Phoenix ICON, 100° FOV. 1240x1240. Wide-field fundus photograph from neonatal ROP screening: 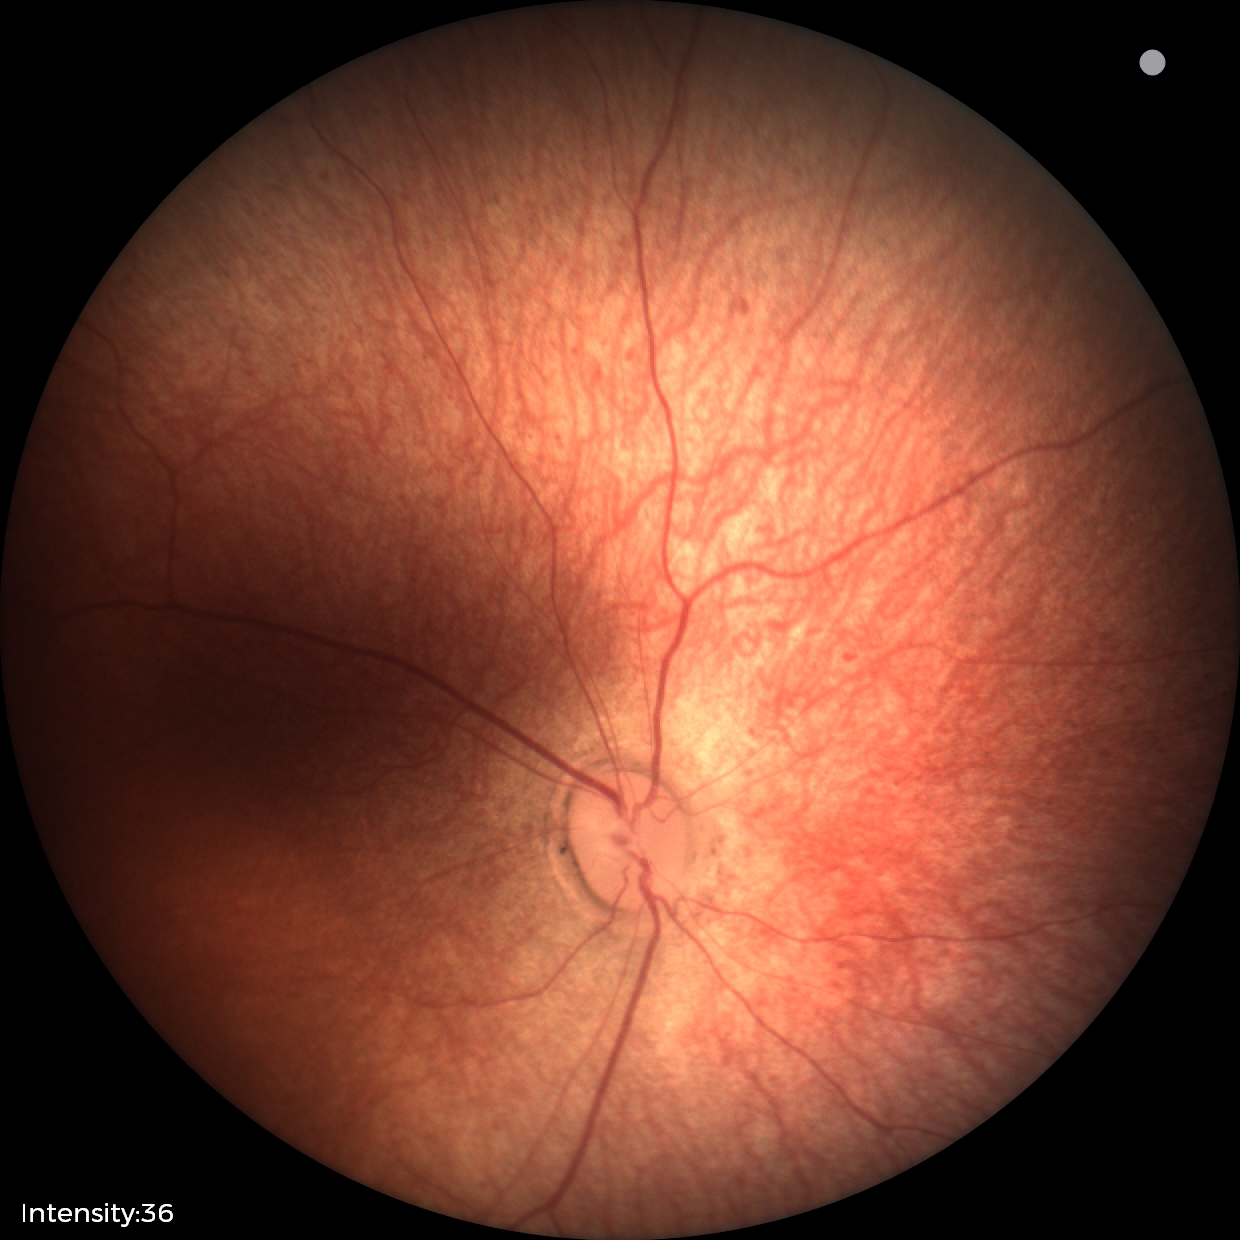 Examination with physiological retinal findings.